Fundus photo taken with a portable handheld camera — 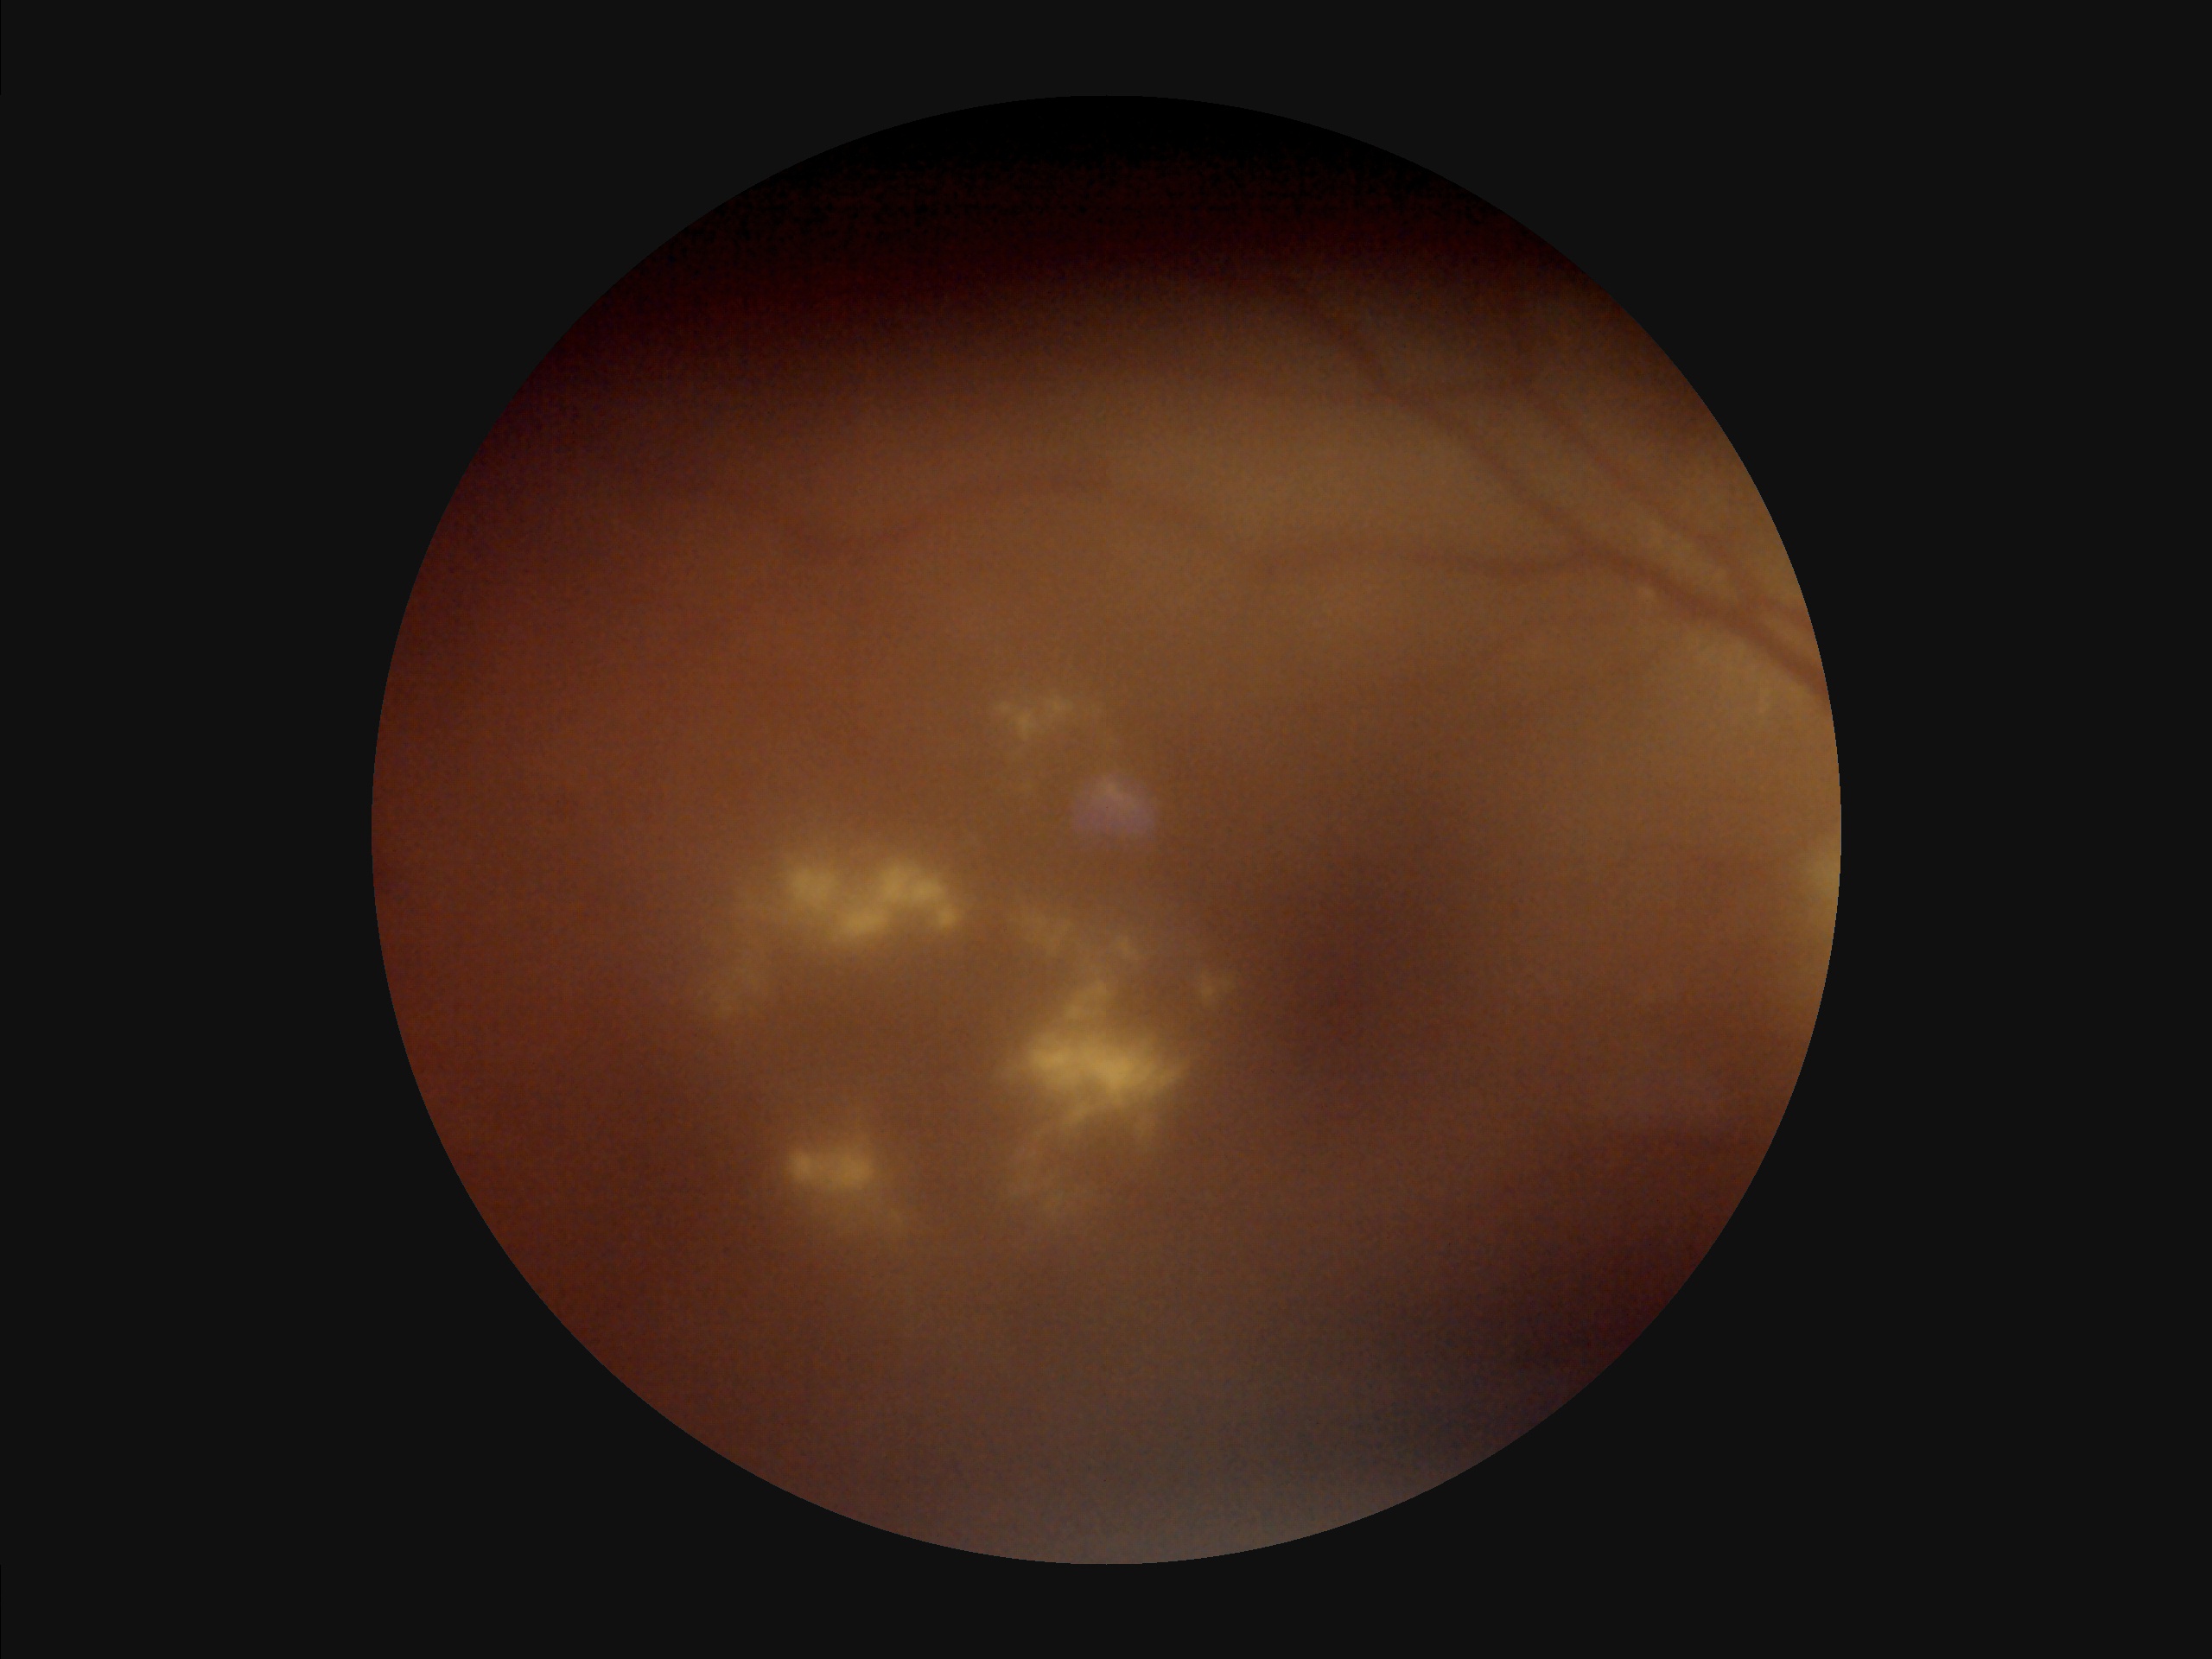

Illumination is uneven.
Noticeable blur in the optic disc, vessels, or background.
Overall image quality is poor.
Narrow intensity range; structures are hard to distinguish.